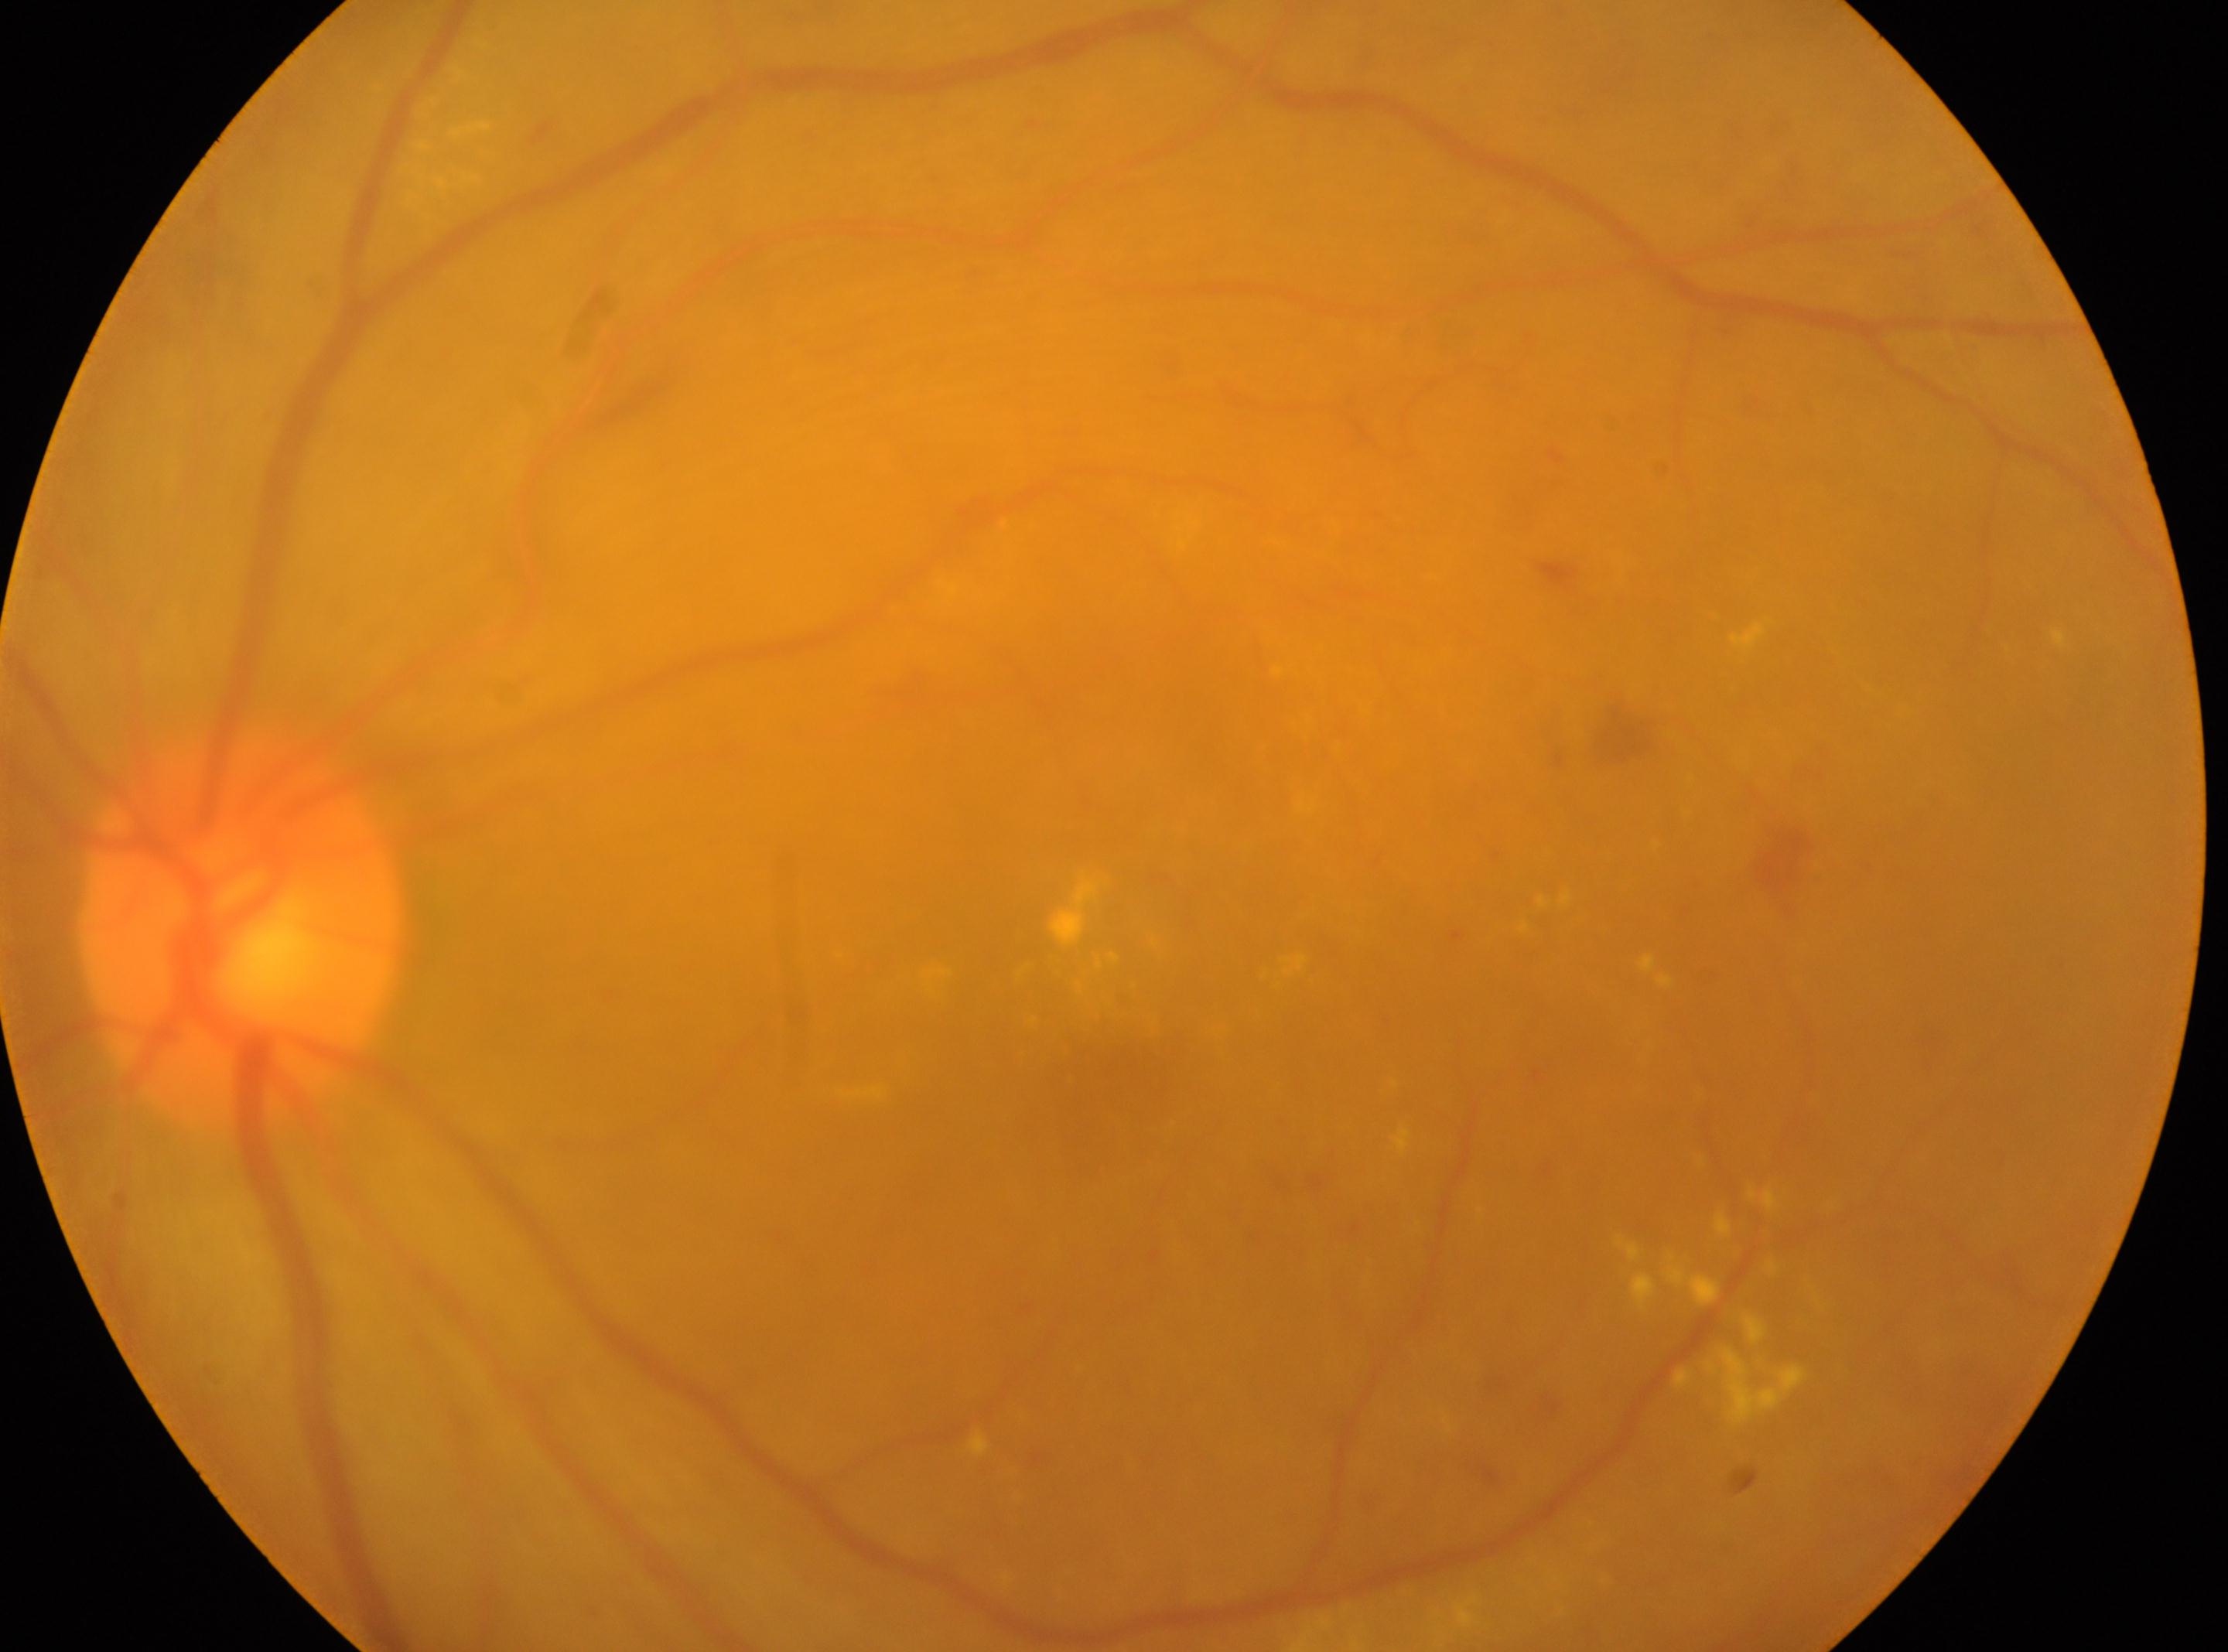

DR: grade 2; optic disc: x=241, y=927; macular center: x=1128, y=1078; eye: OS.